Wide-field contact fundus photograph of an infant — 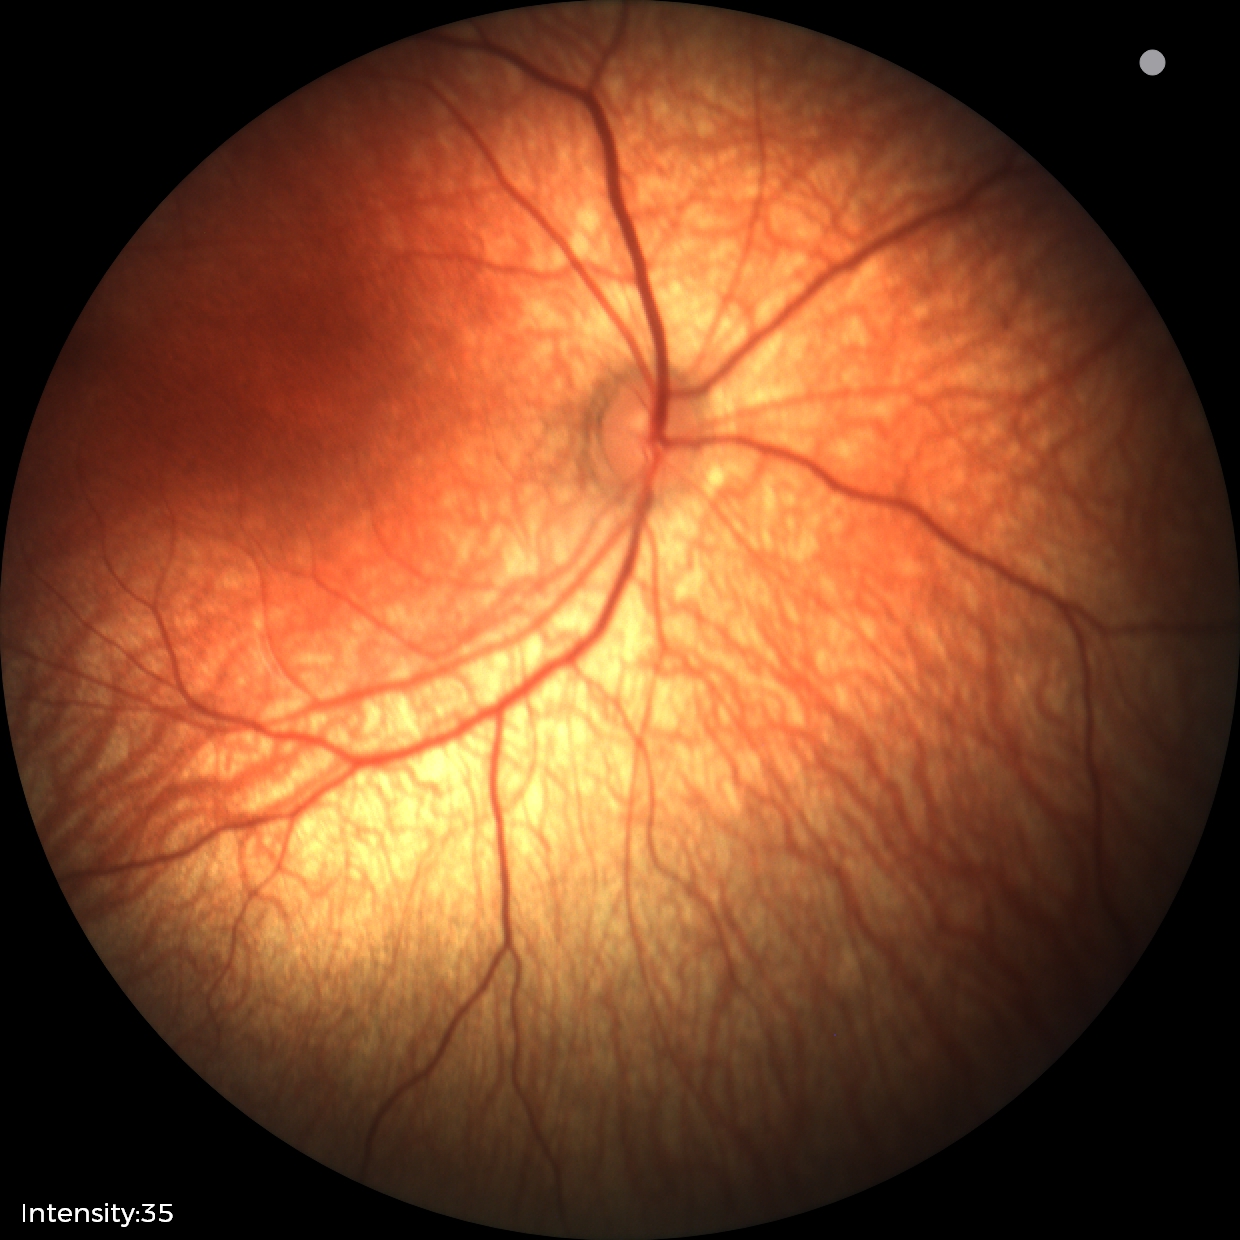
Screening diagnosis: no abnormal retinal findings.